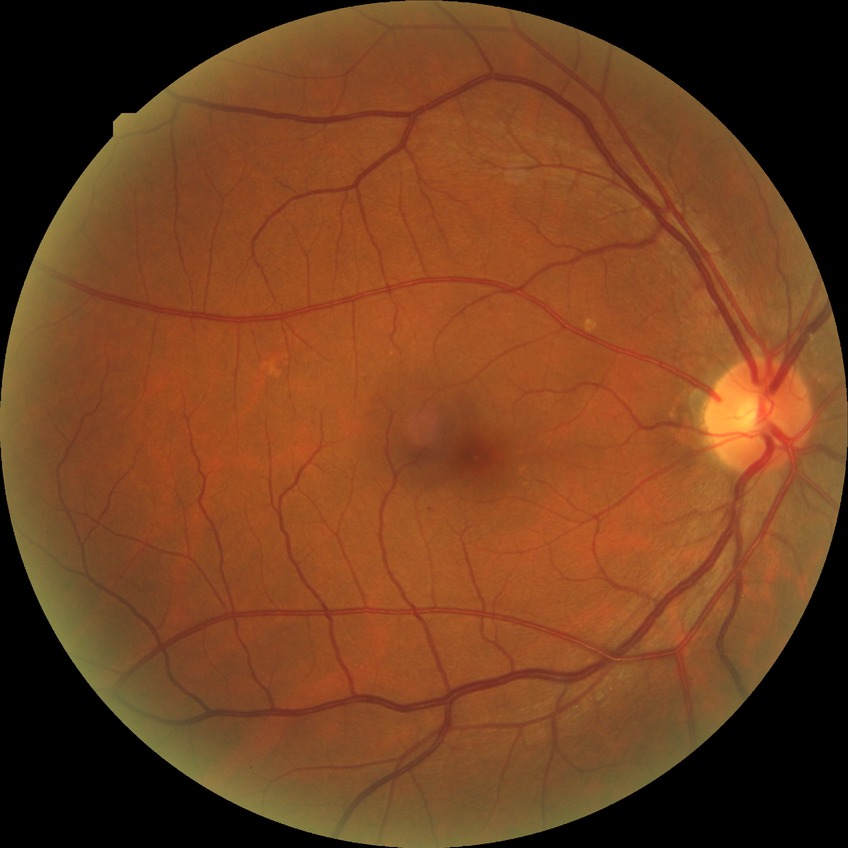
Findings:
* modified Davis grading — simple diabetic retinopathy